45-degree field of view — 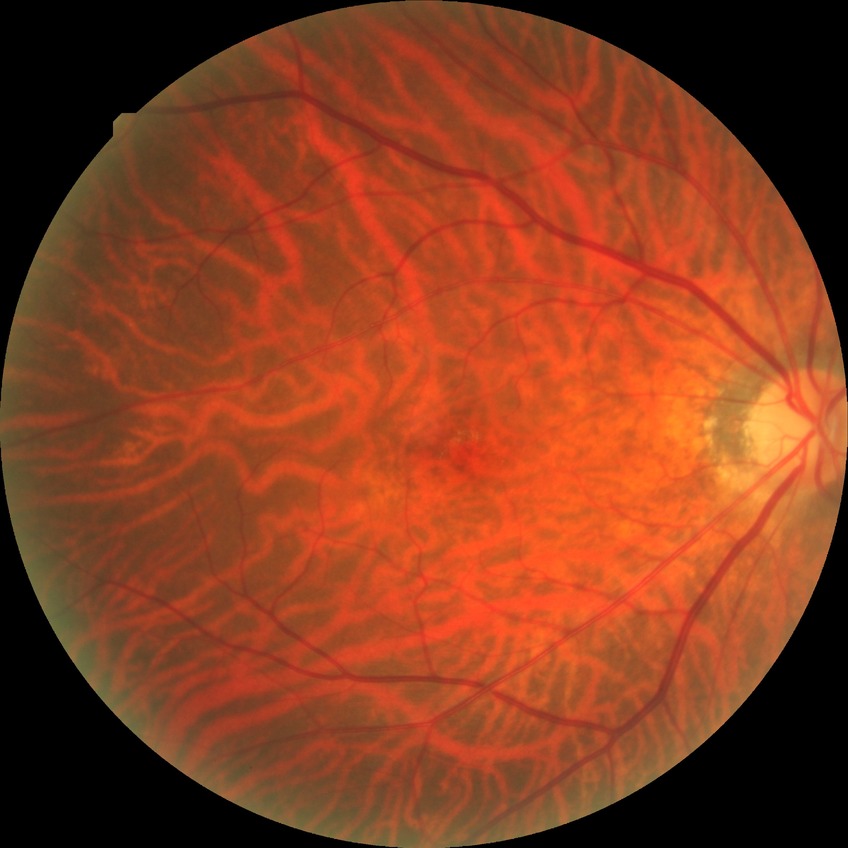
Diabetic retinopathy (DR): NDR (no diabetic retinopathy).